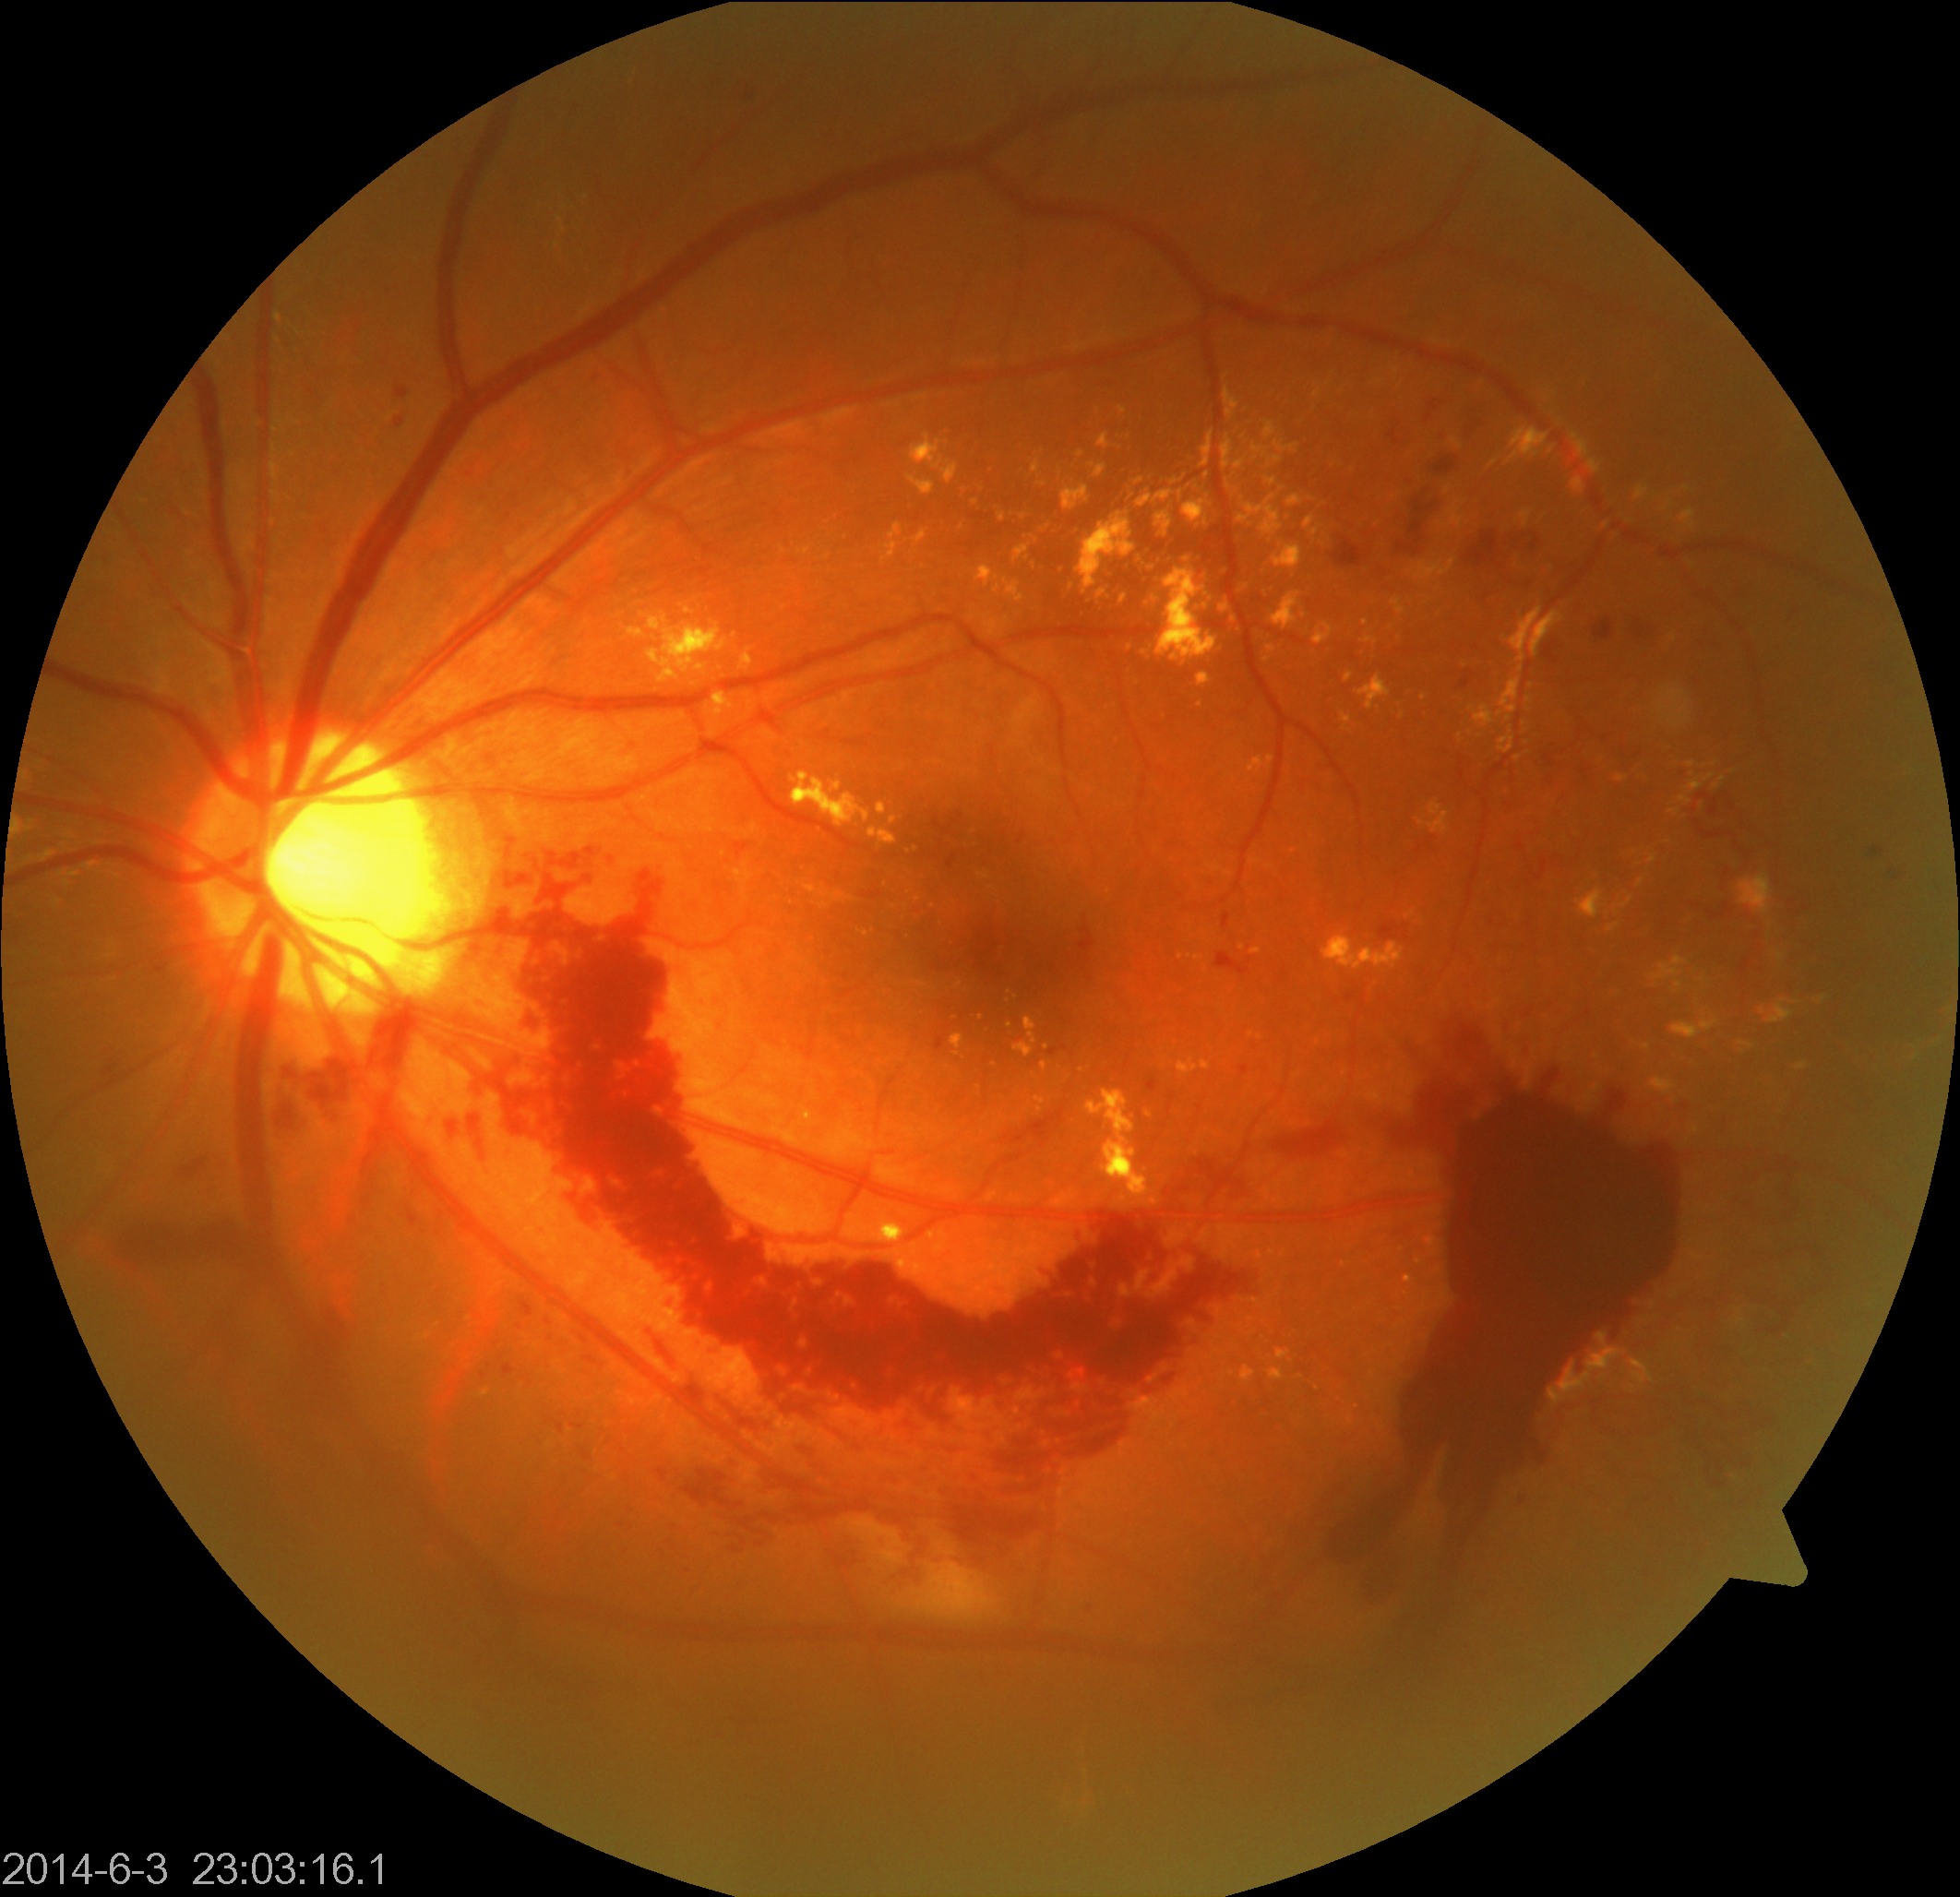 Findings: severe non-proliferative or proliferative diabetic retinopathy.